Retinal fundus photograph — 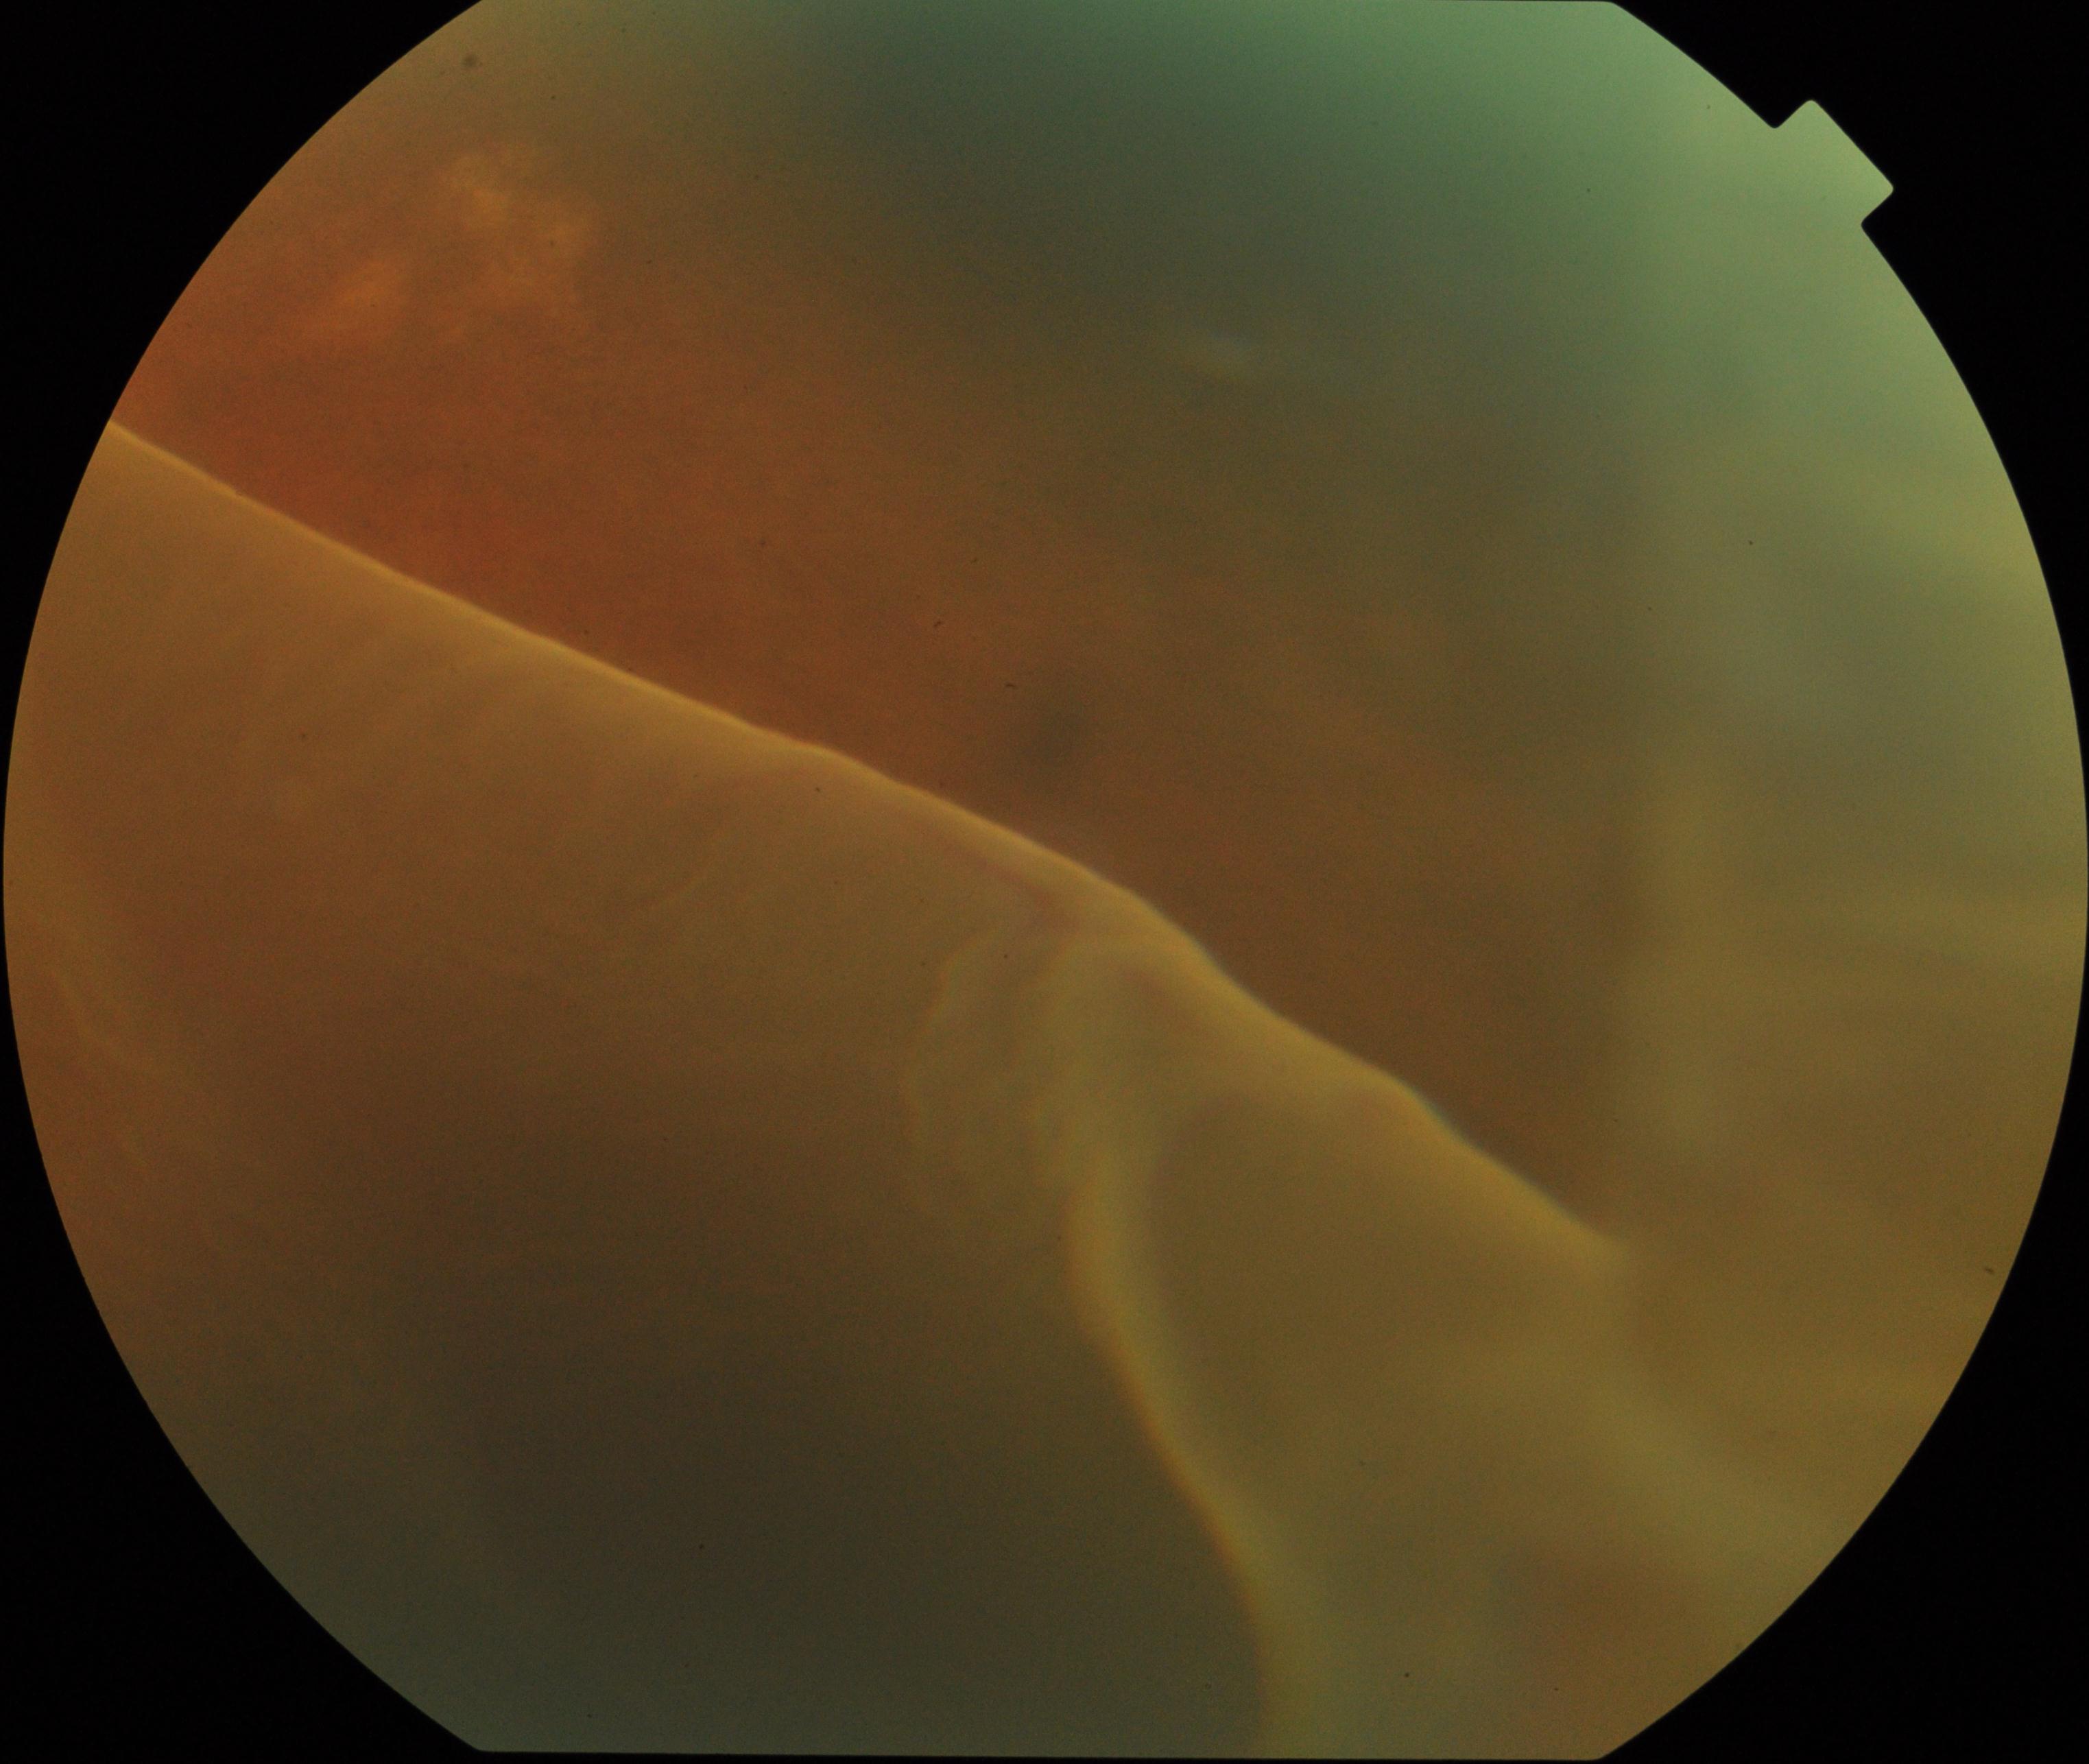

The image shows rhegmatogenous retinal detachment.